CFP; 1932x1932; FOV: 45 degrees.
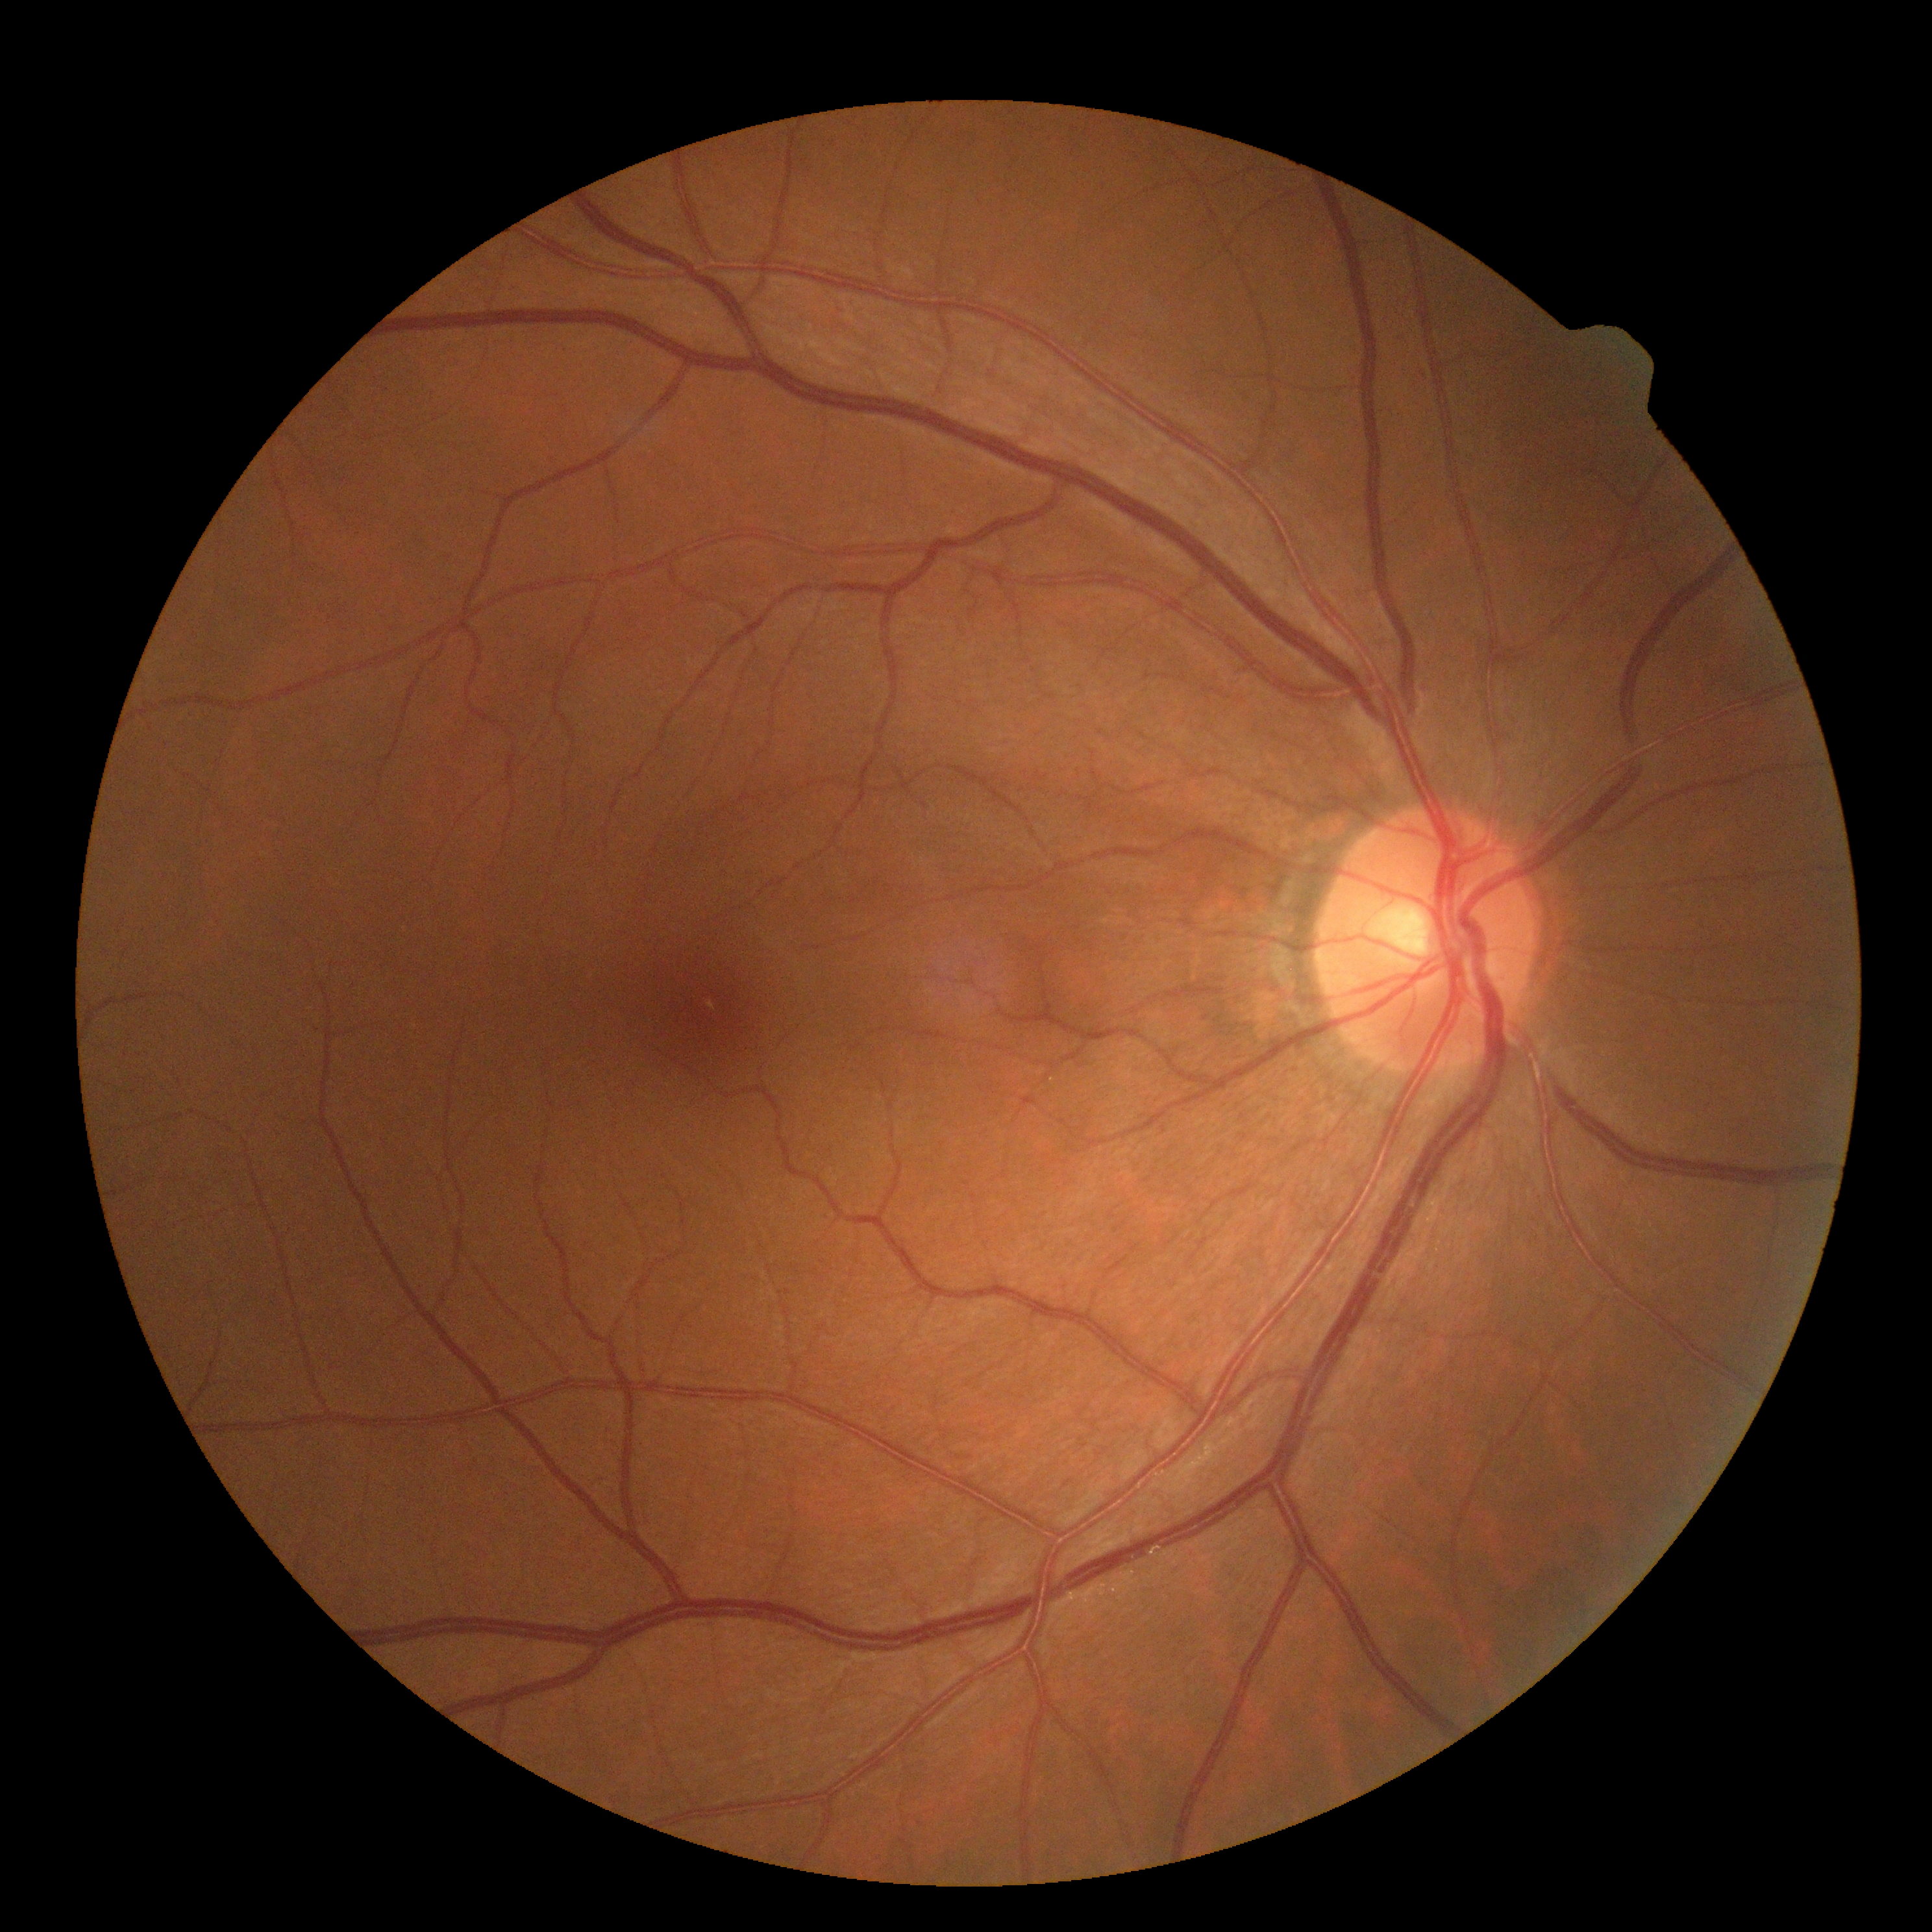
Diabetic retinopathy: grade 0 (no apparent retinopathy).